Fundus photo · 1924 by 1556 pixels
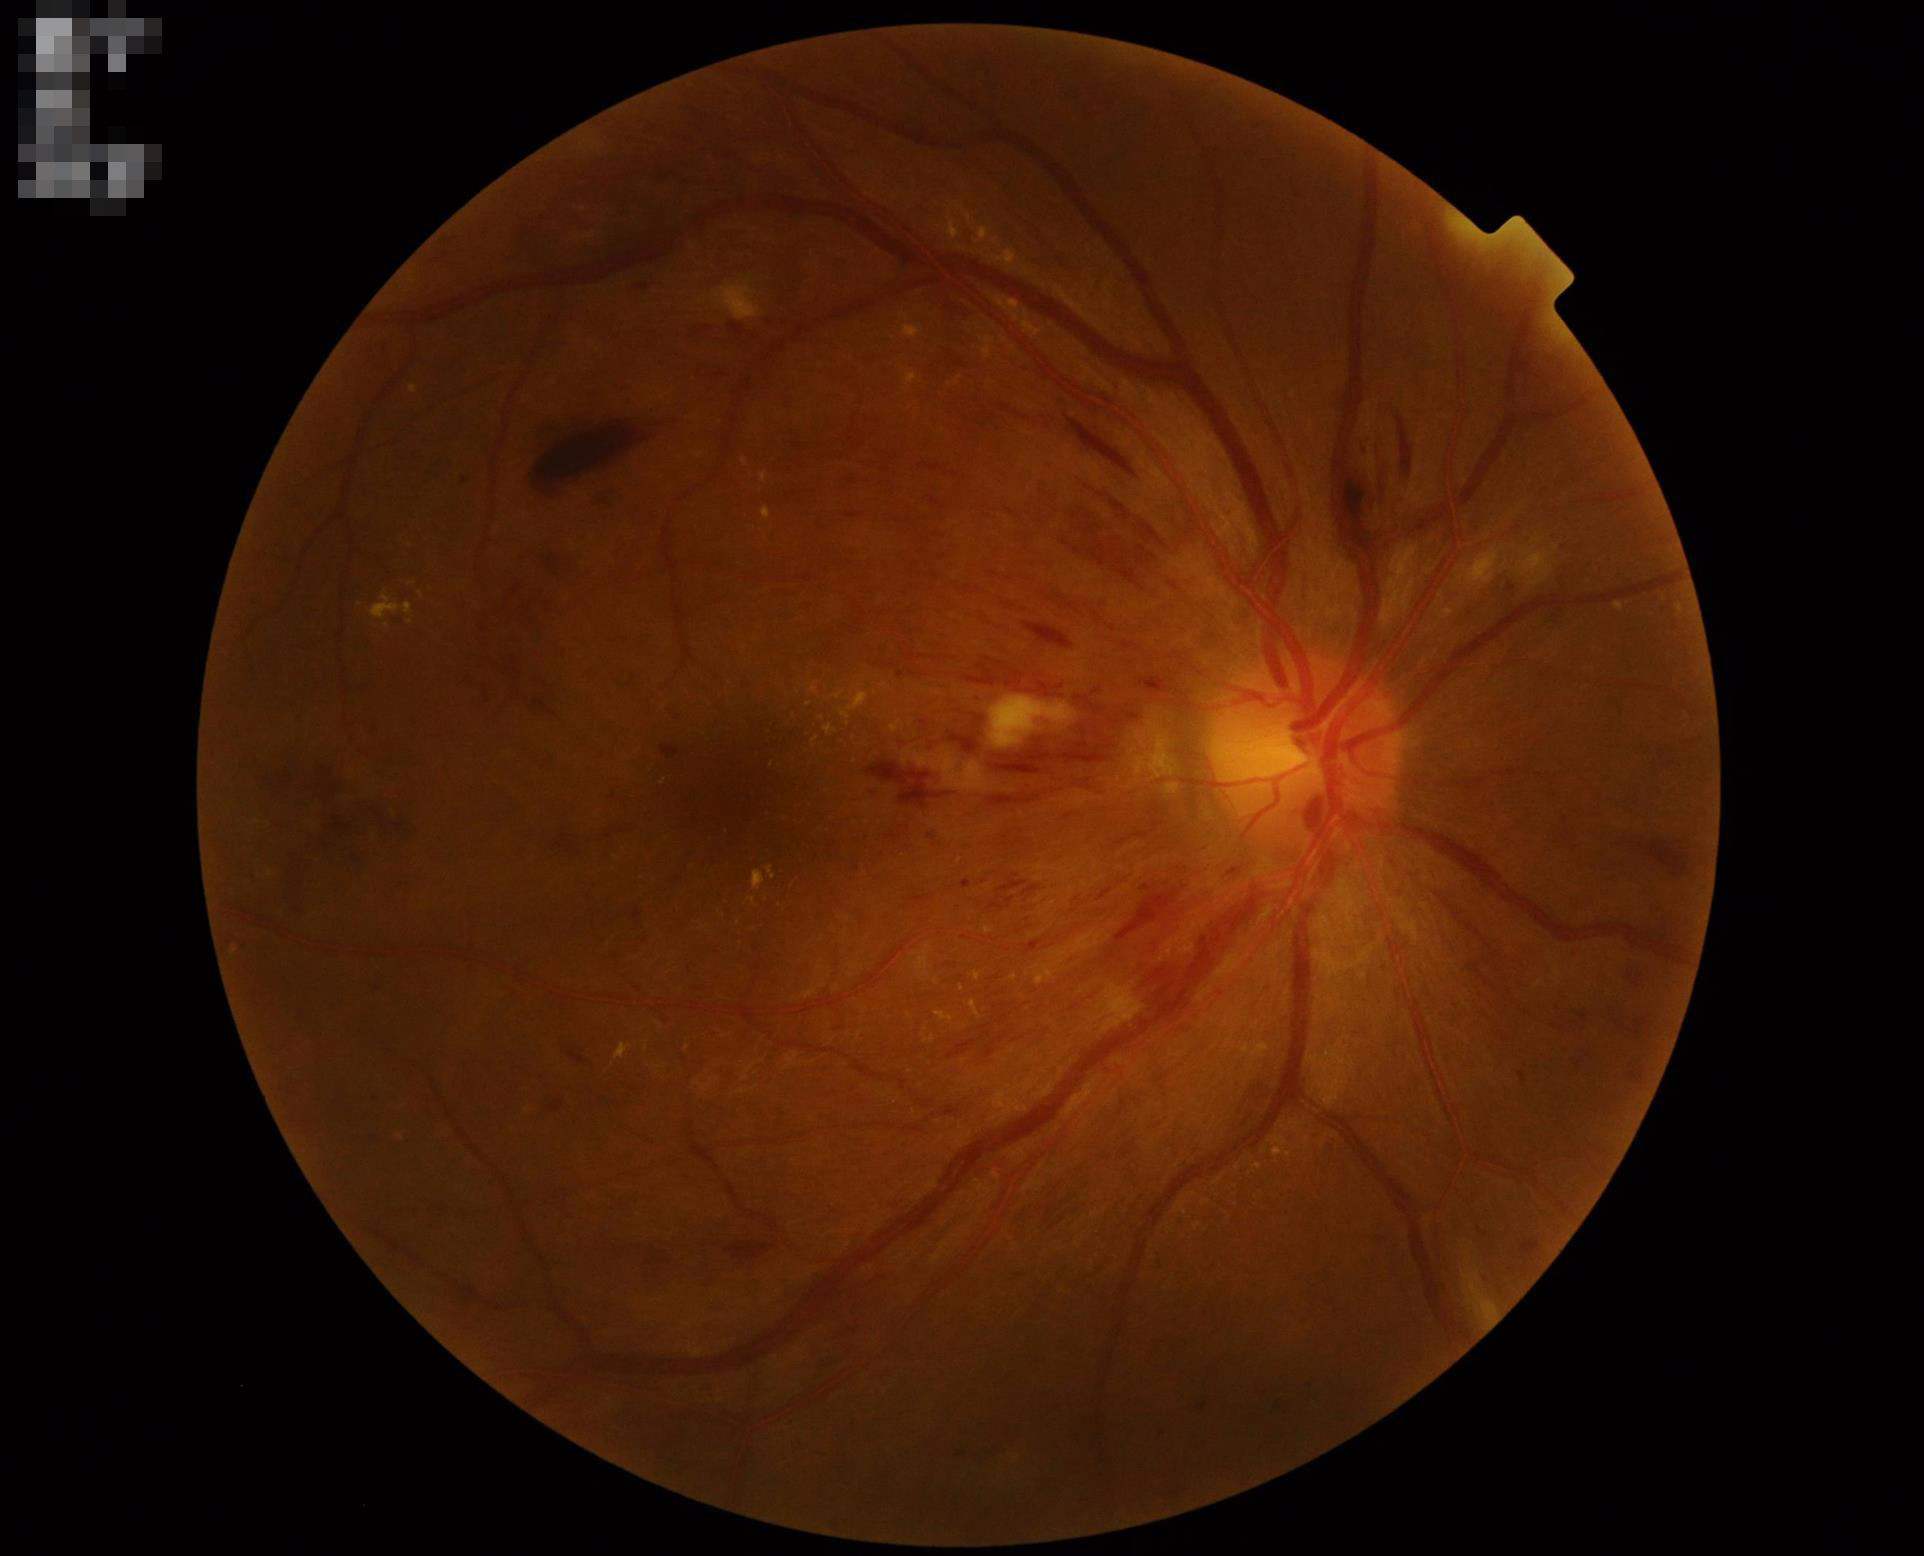 Image quality is adequate for diagnostic use. Illumination and color balance are good.